CFP, Davis DR grading.
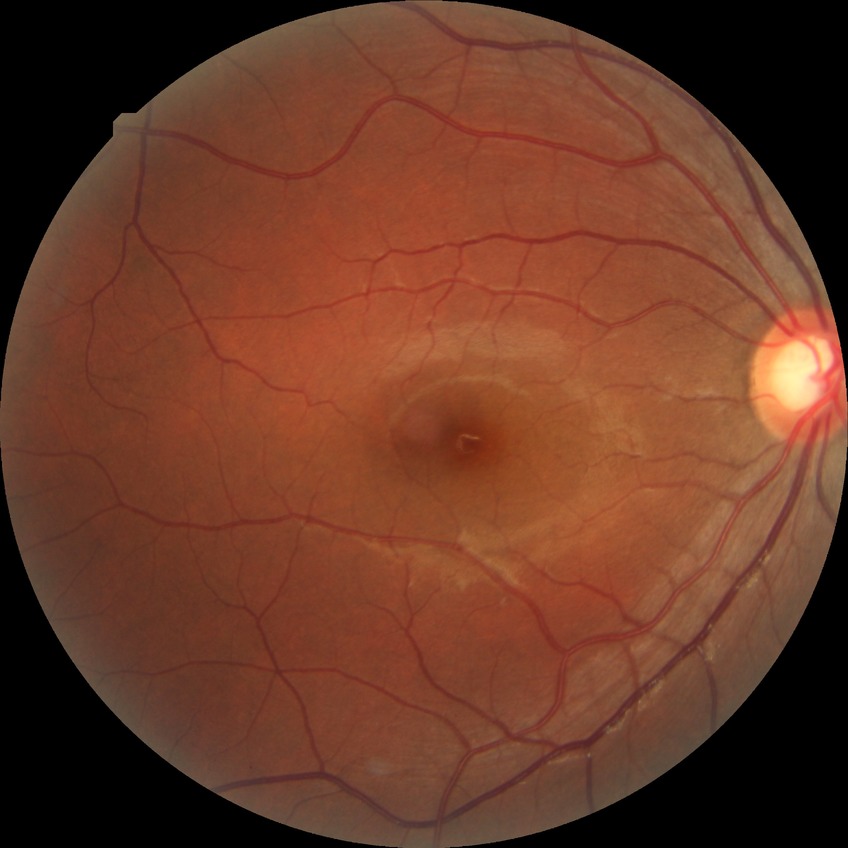 Annotations:
• DR class: non-proliferative diabetic retinopathy
• modified Davis classification: simple diabetic retinopathy